Camera: Phoenix ICON (100° FOV); wide-field fundus image from infant ROP screening; 1240 x 1240 pixels.
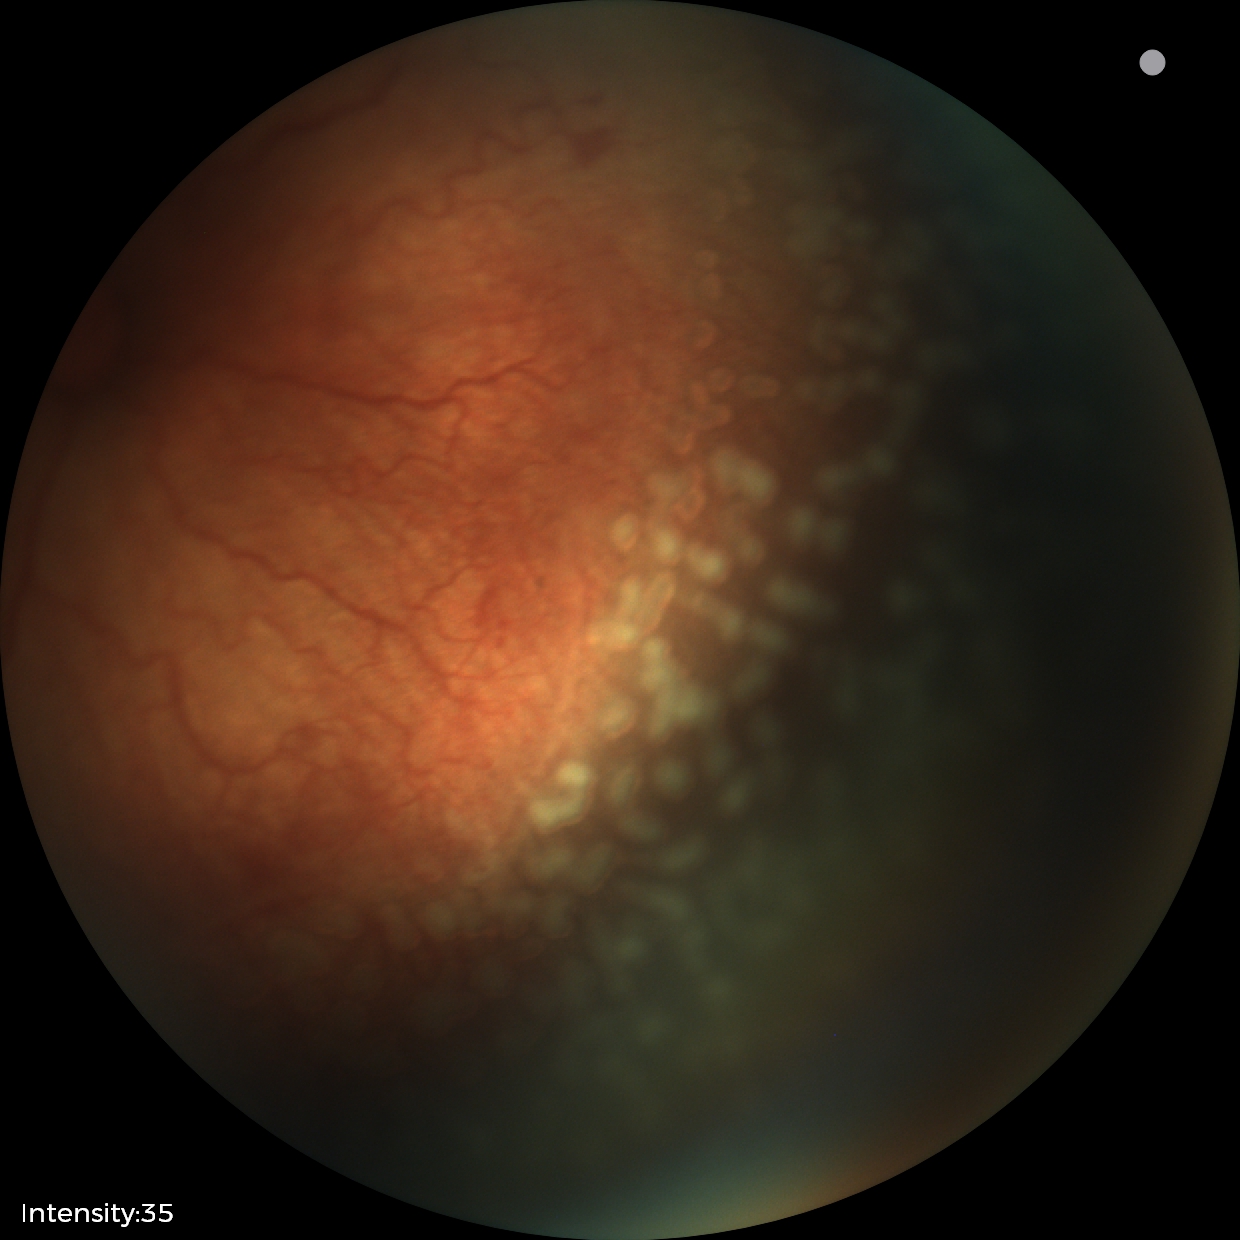
Impression: plus disease; retinopathy of prematurity stage 2.